Color fundus photograph; 2048x1536px.
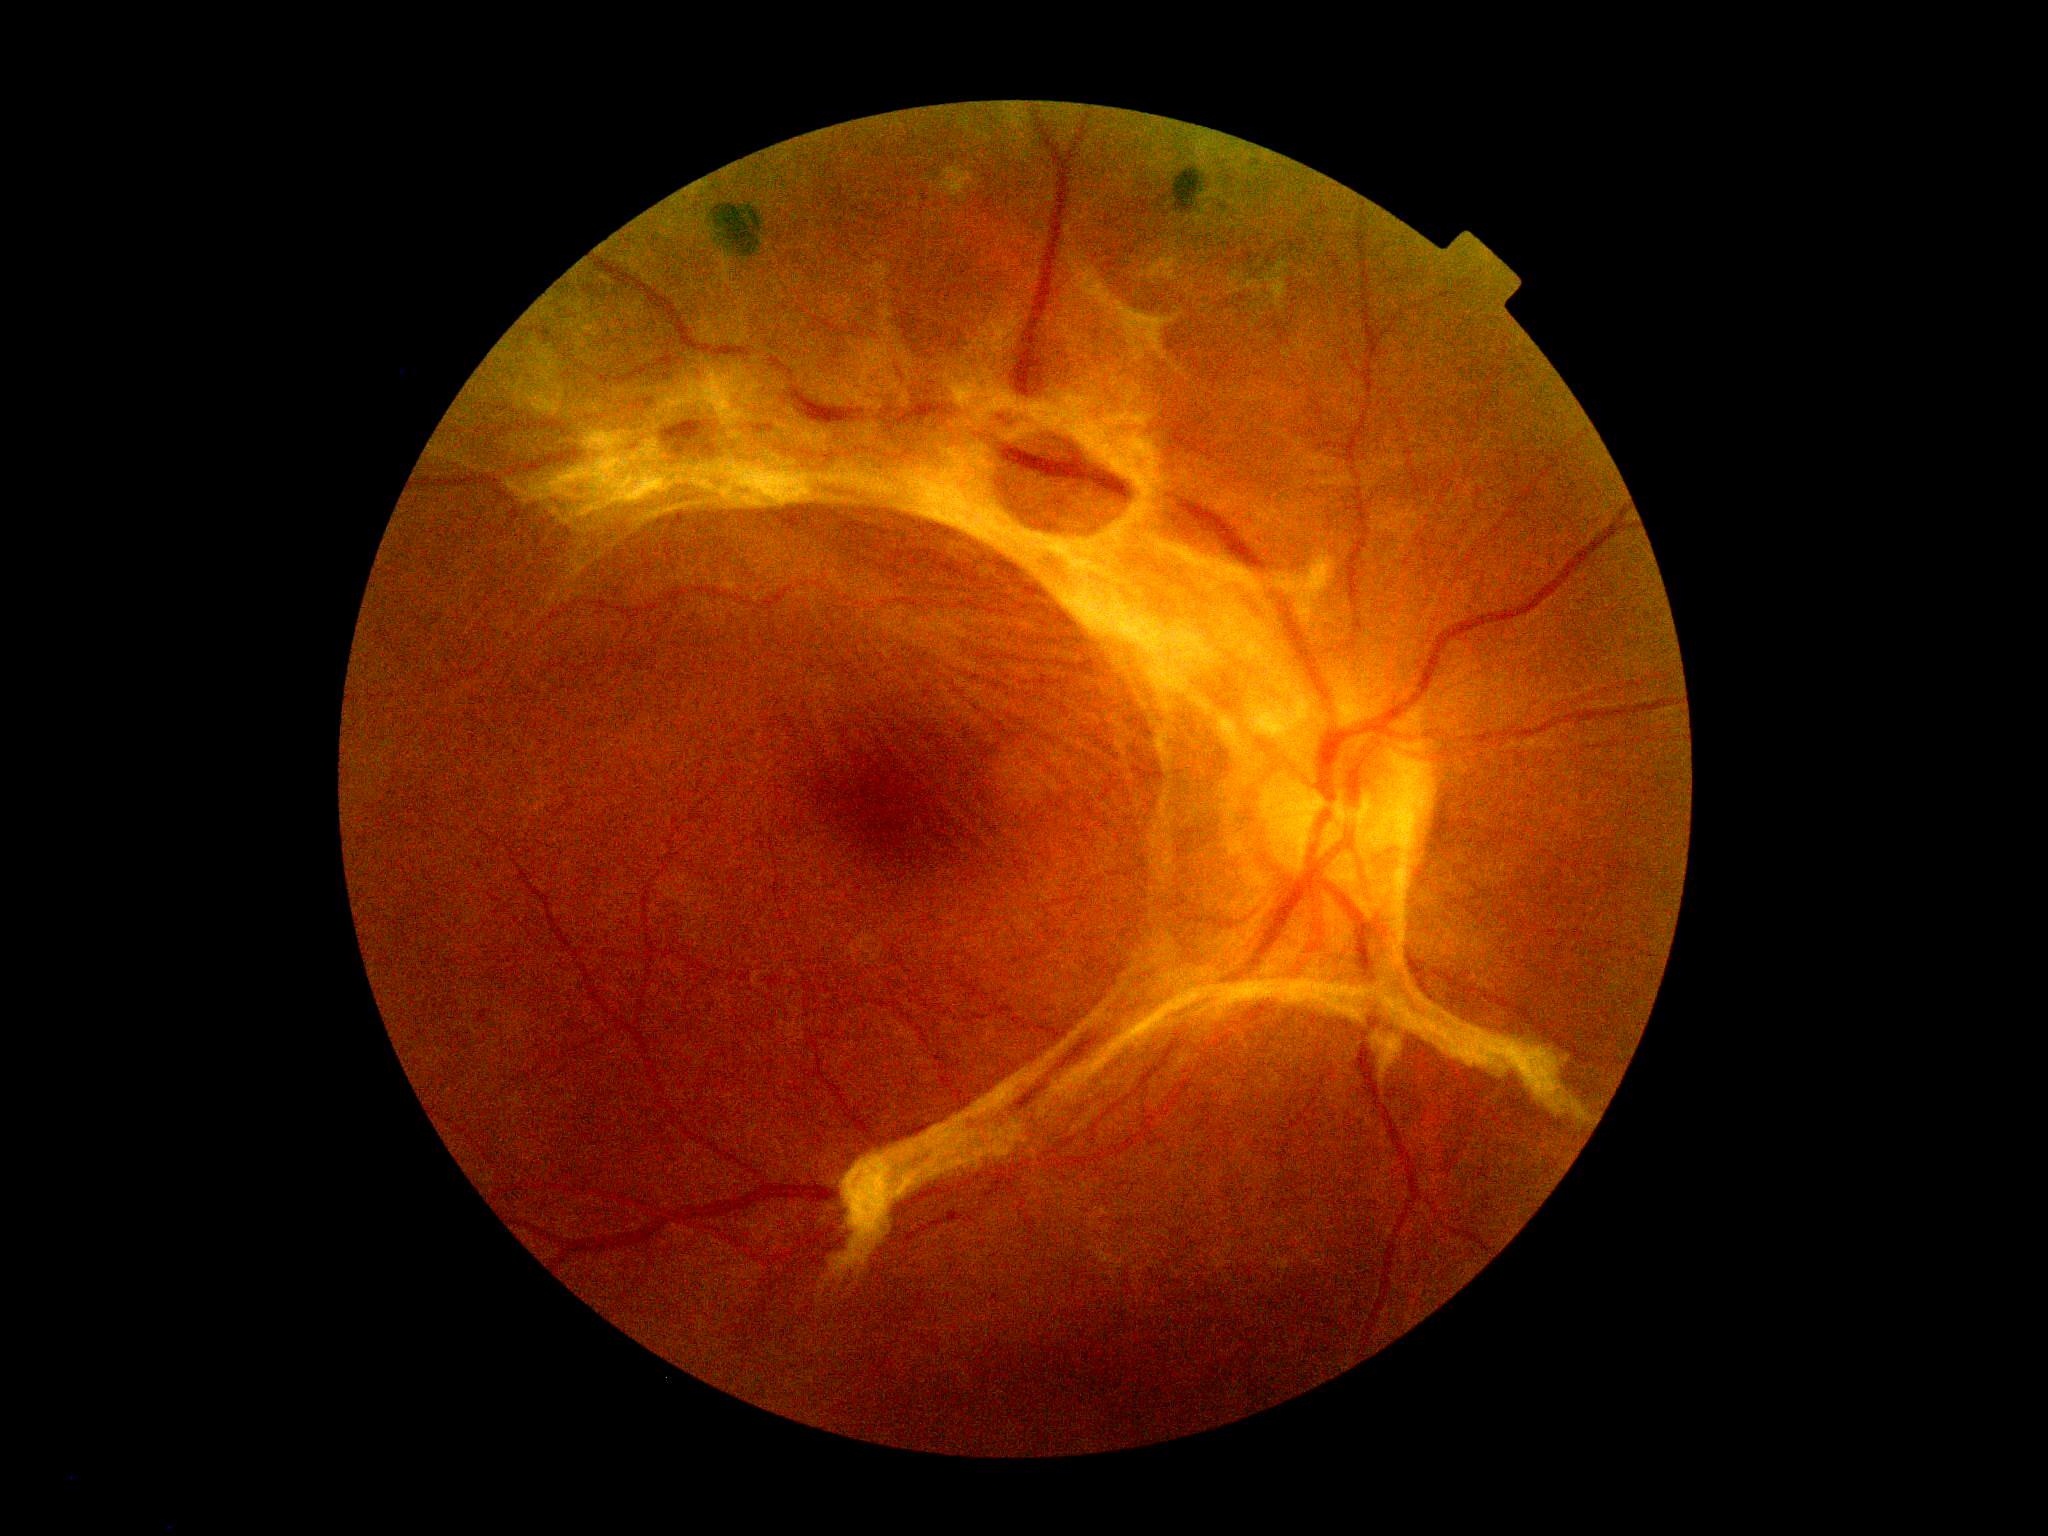

Diabetic retinopathy (DR) is 4.